Refractive error: sphere +0.5 D, cylinder -1 D, axis 90°; 2212x1661; FOV: 30 degrees; IOP 19 mmHg; axial length (AL): 23.33 mm; central corneal thickness 599 µm; non-mydriatic.
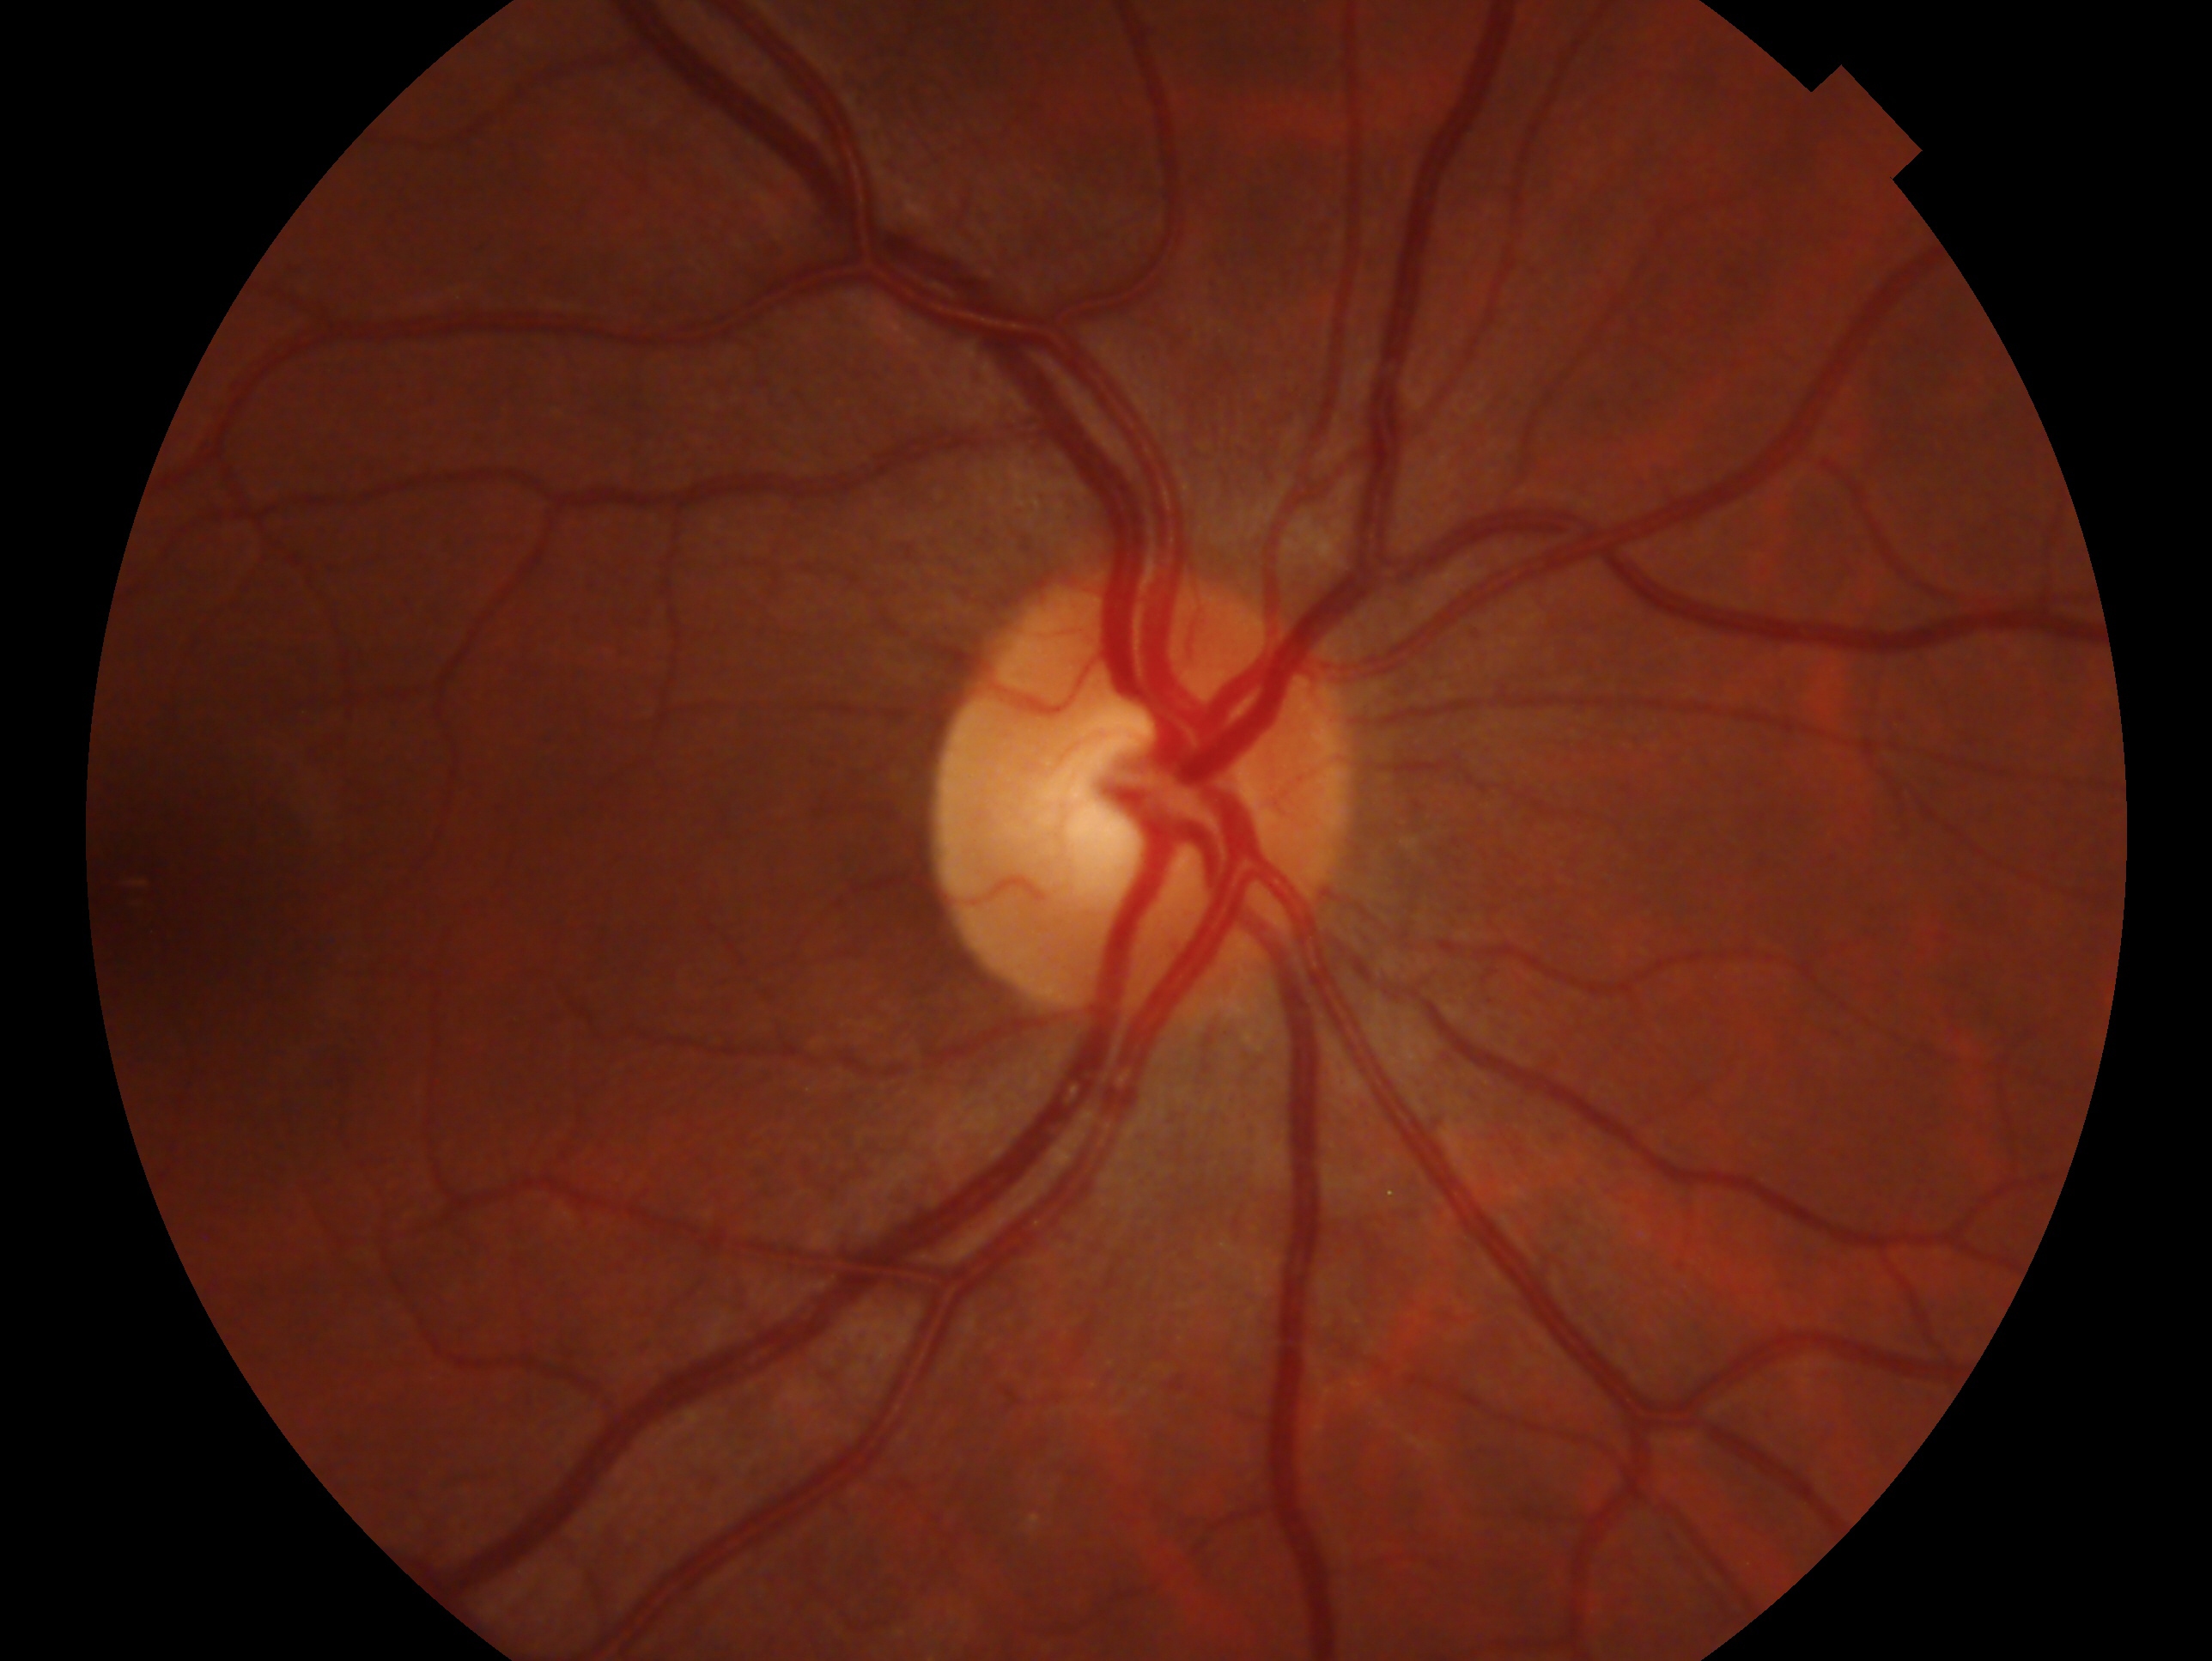
Q: Glaucoma assessment?
A: negative for glaucoma — no clinical evidence of glaucoma in this eye
Q: Which eye is imaged?
A: right